45° FOV; 1932x1910px; color fundus image
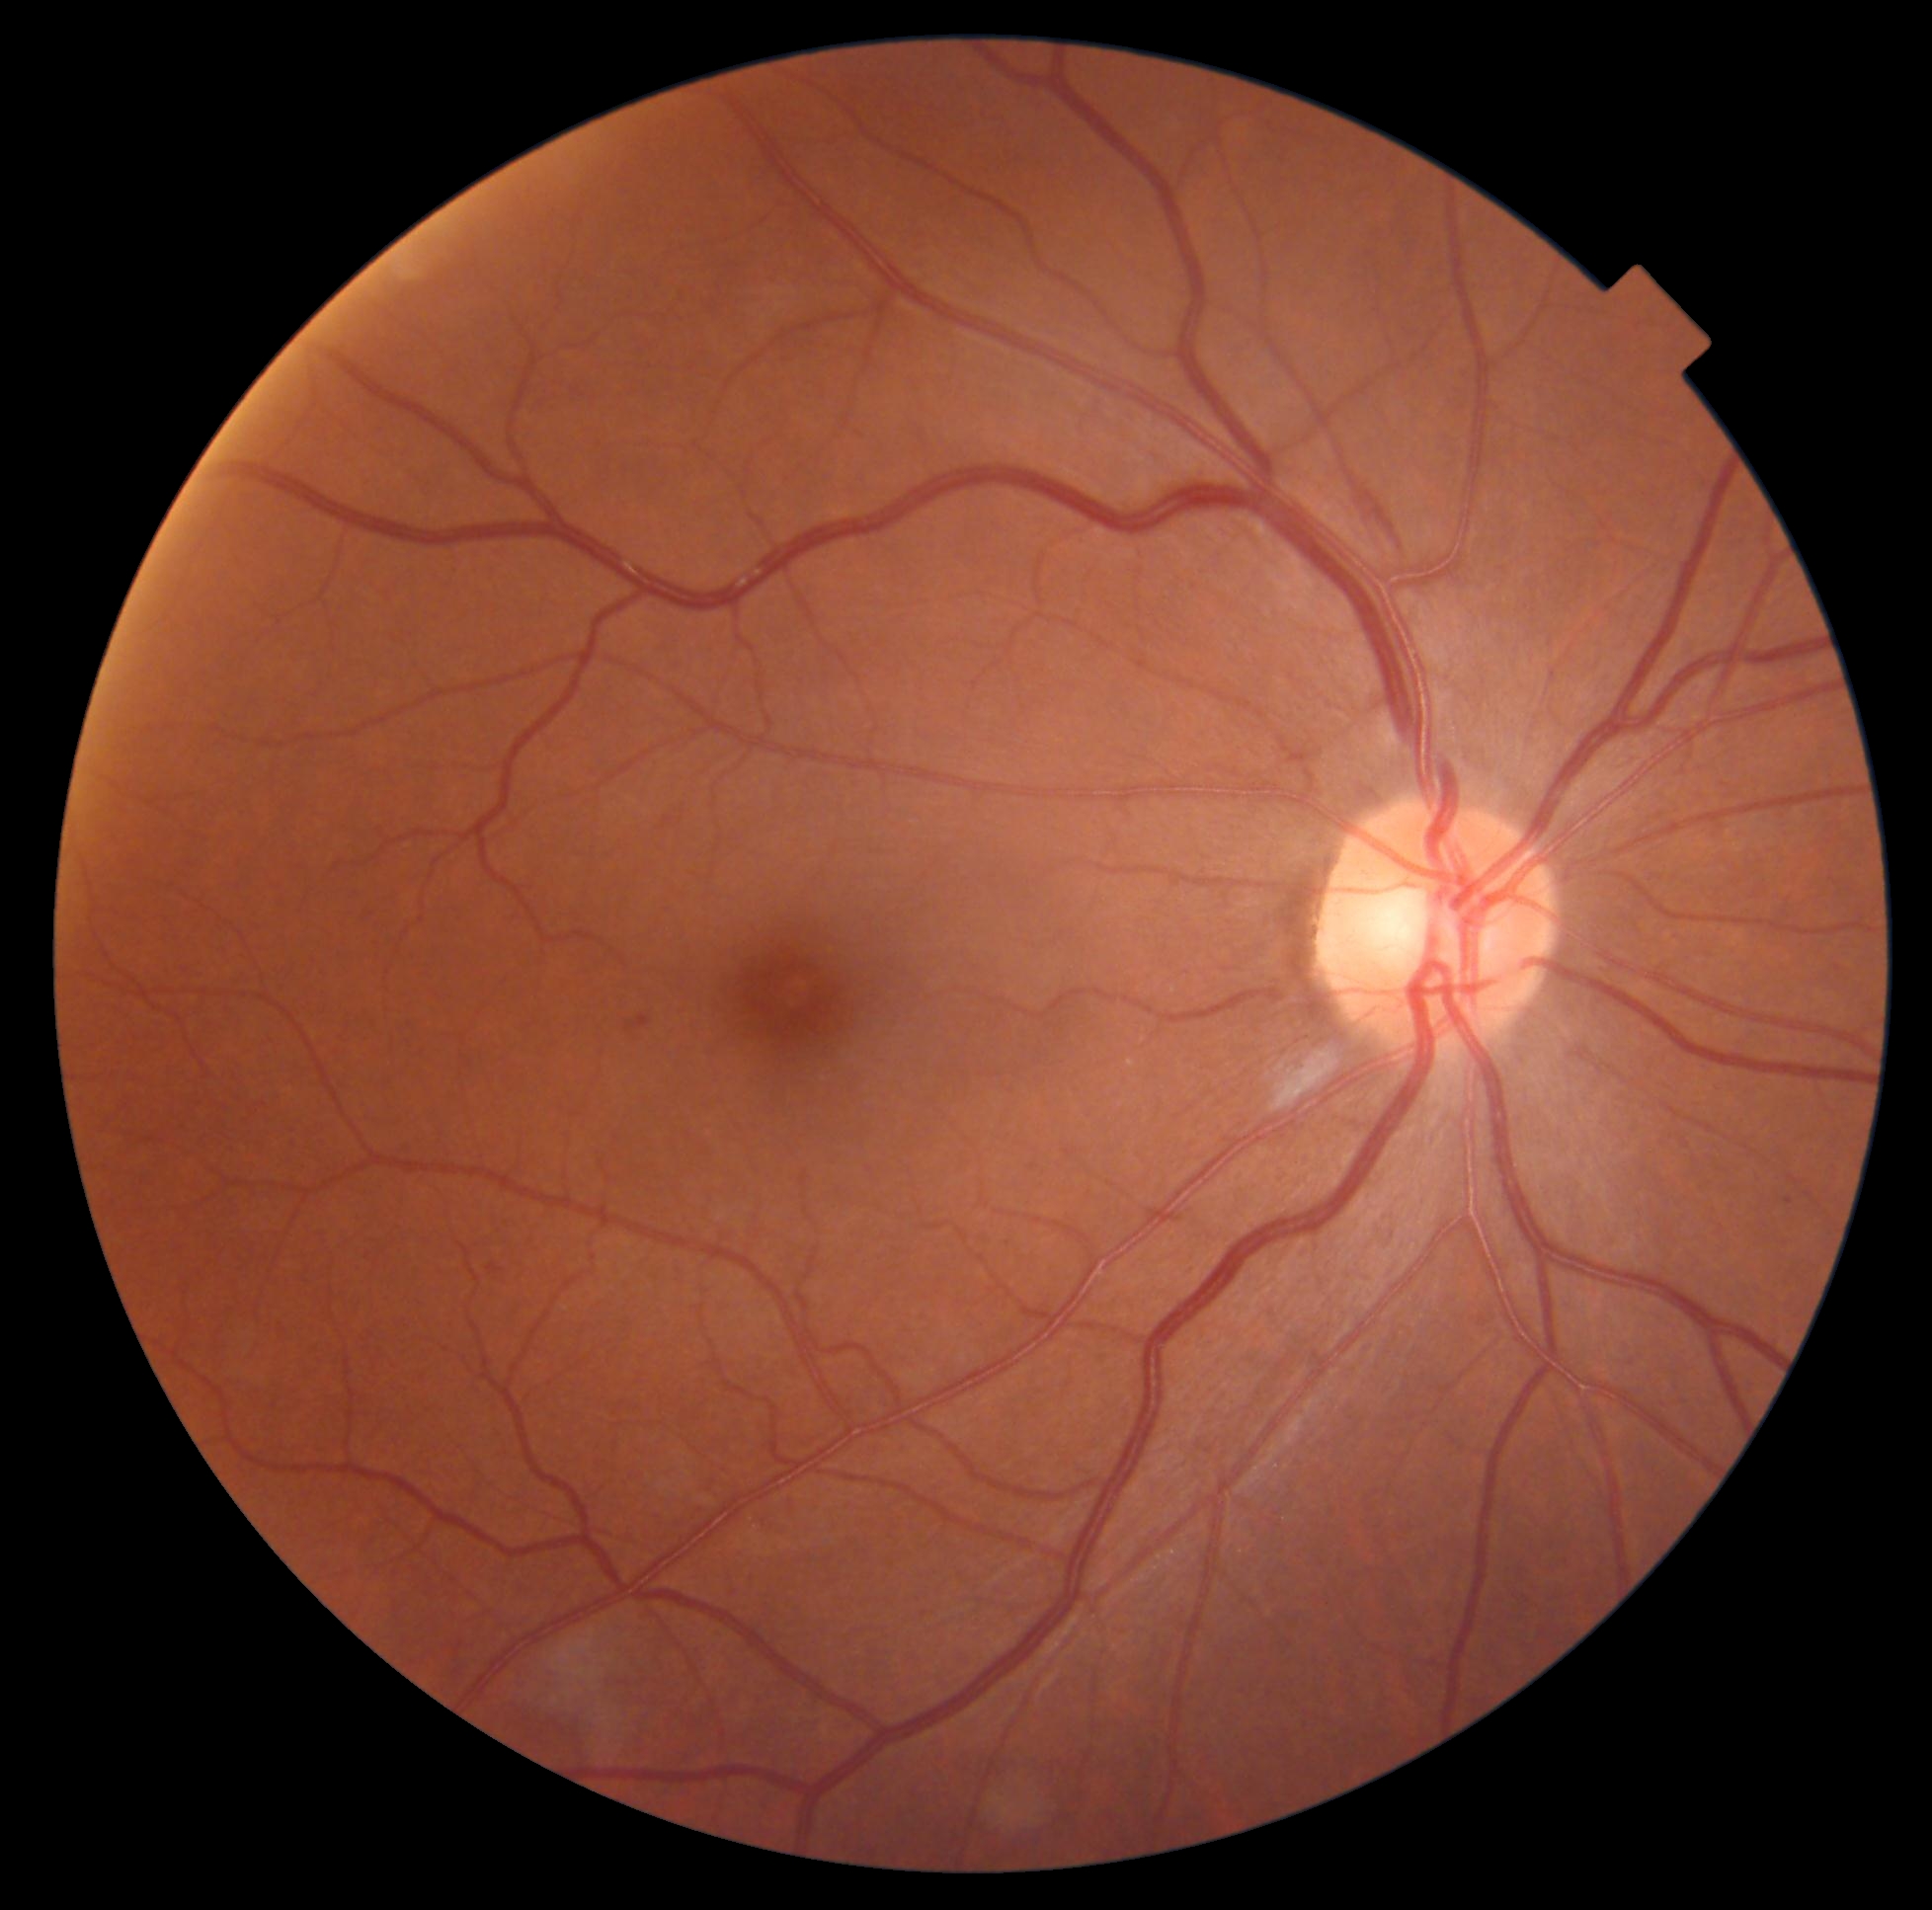 Diabetic retinopathy (DR) is moderate non-proliferative diabetic retinopathy (grade 2).